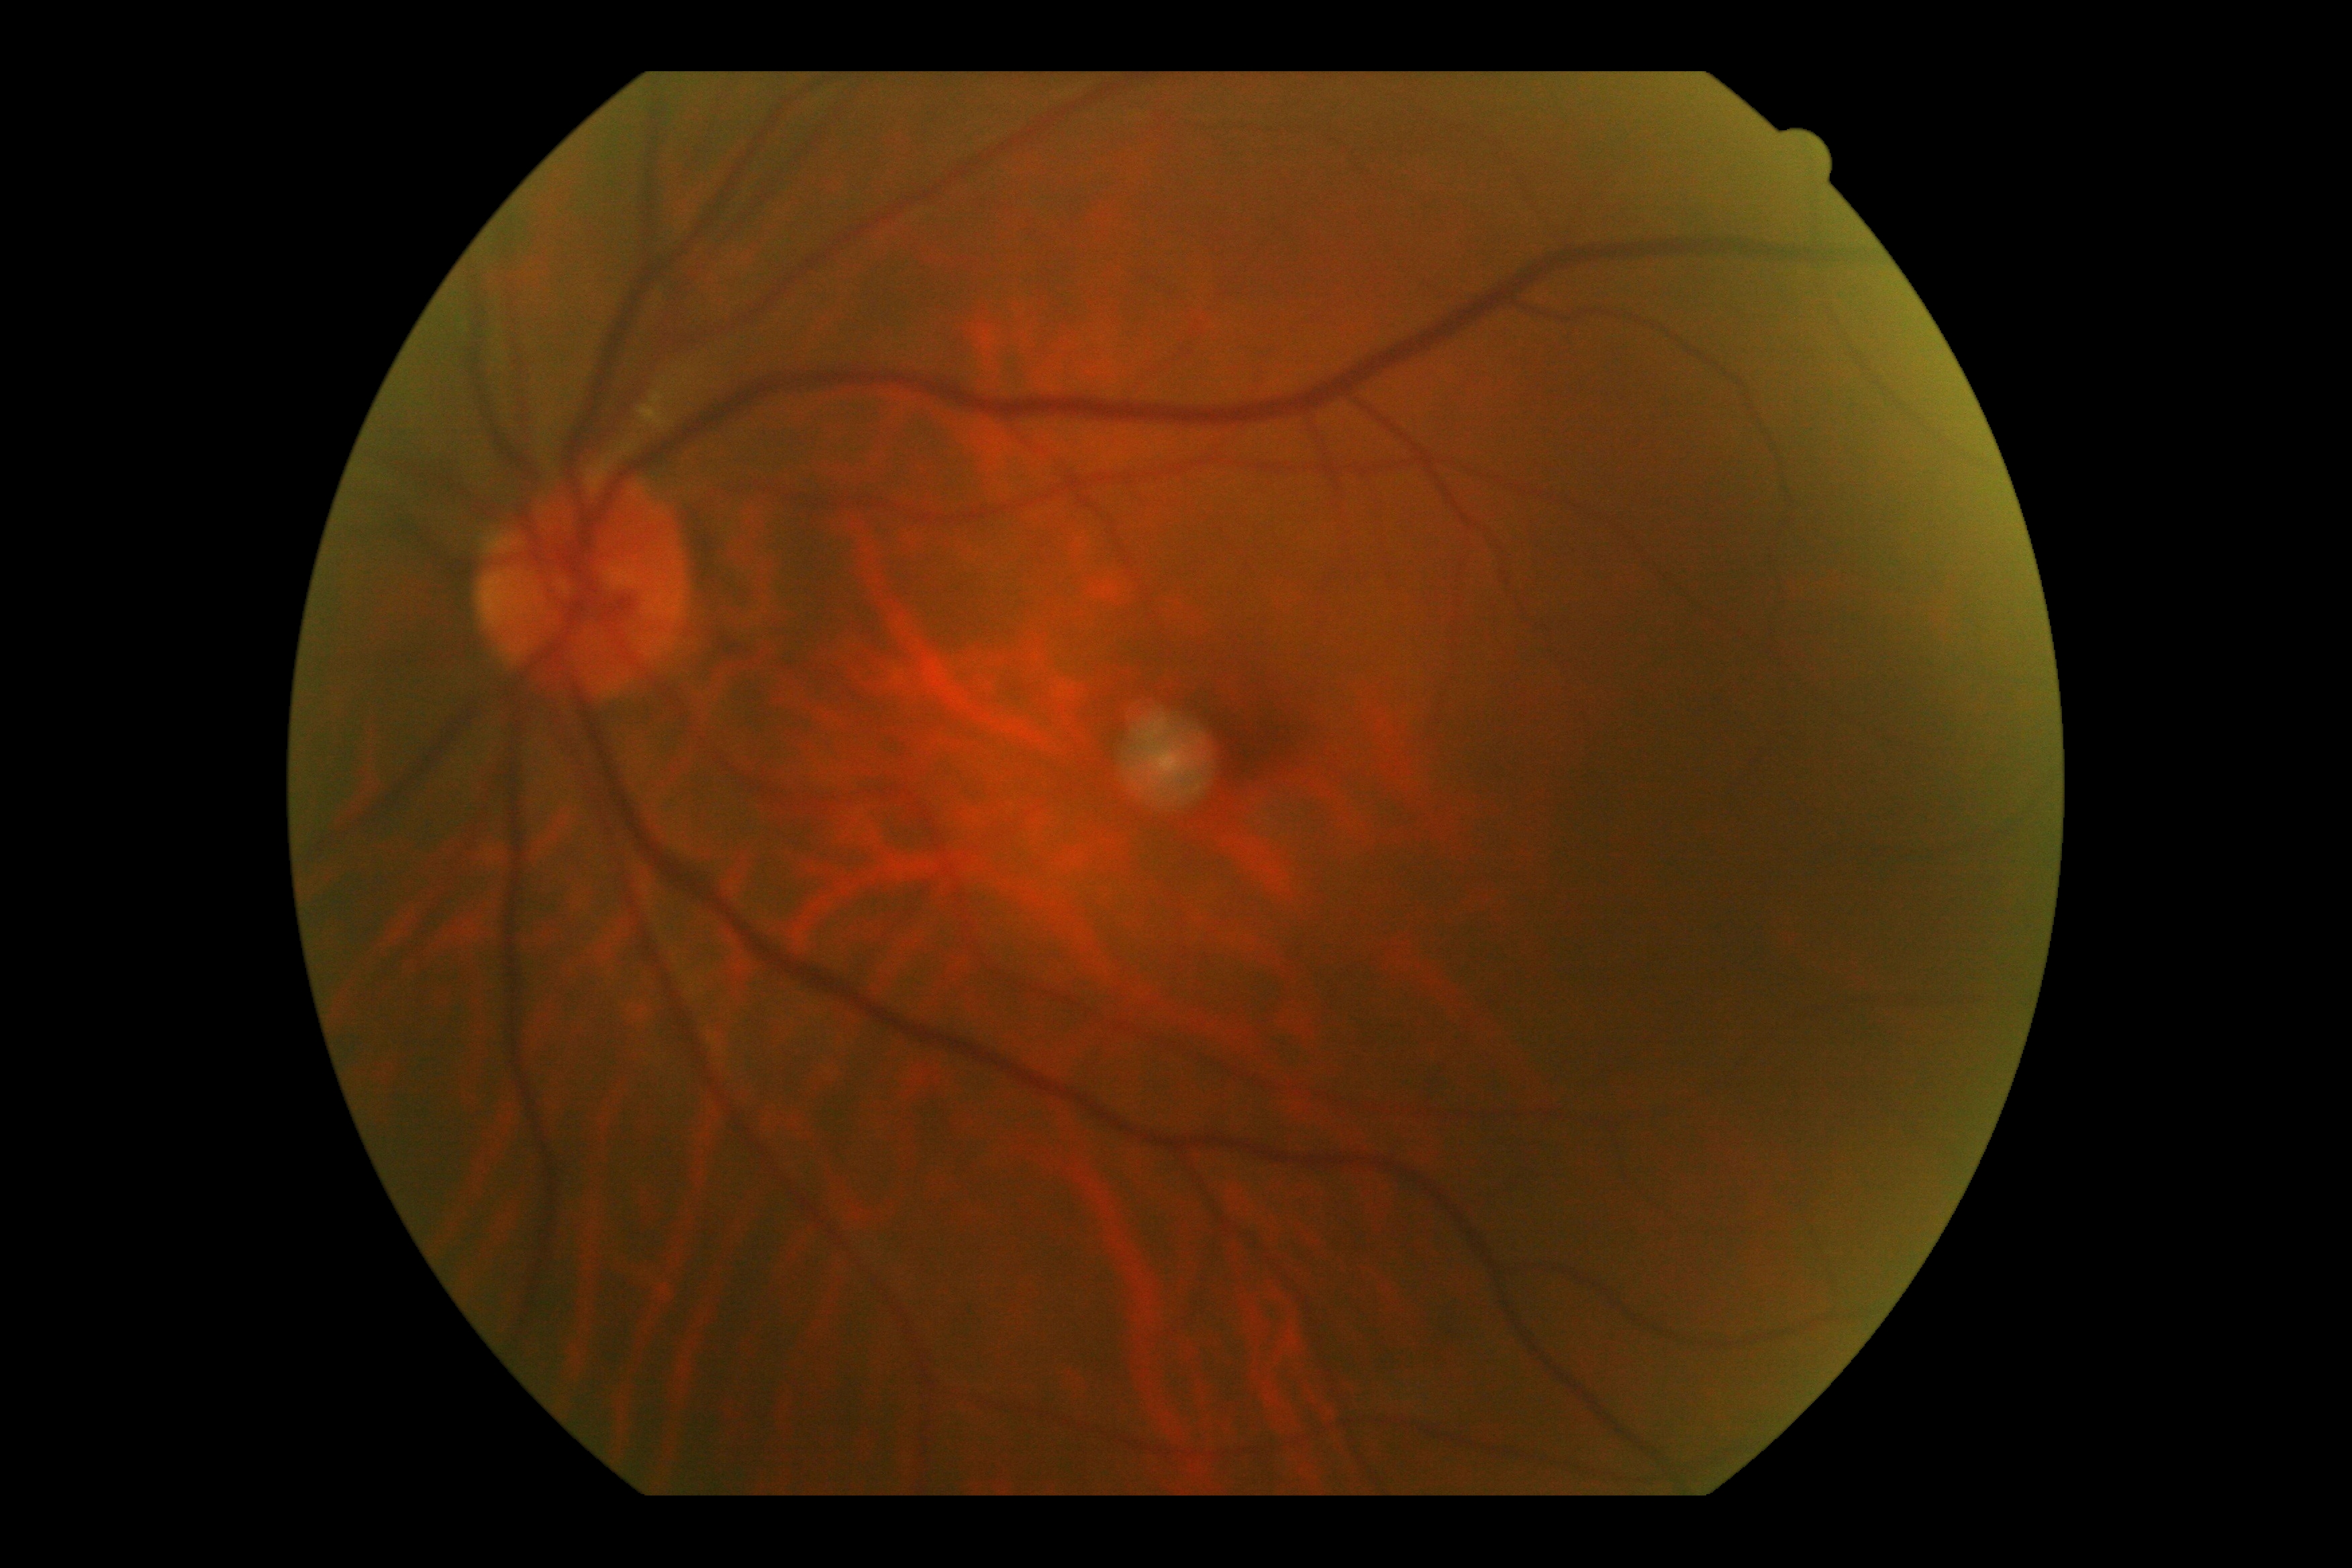

Findings:
- diabetic retinopathy — 0